Ultra-widefield fundus photograph: 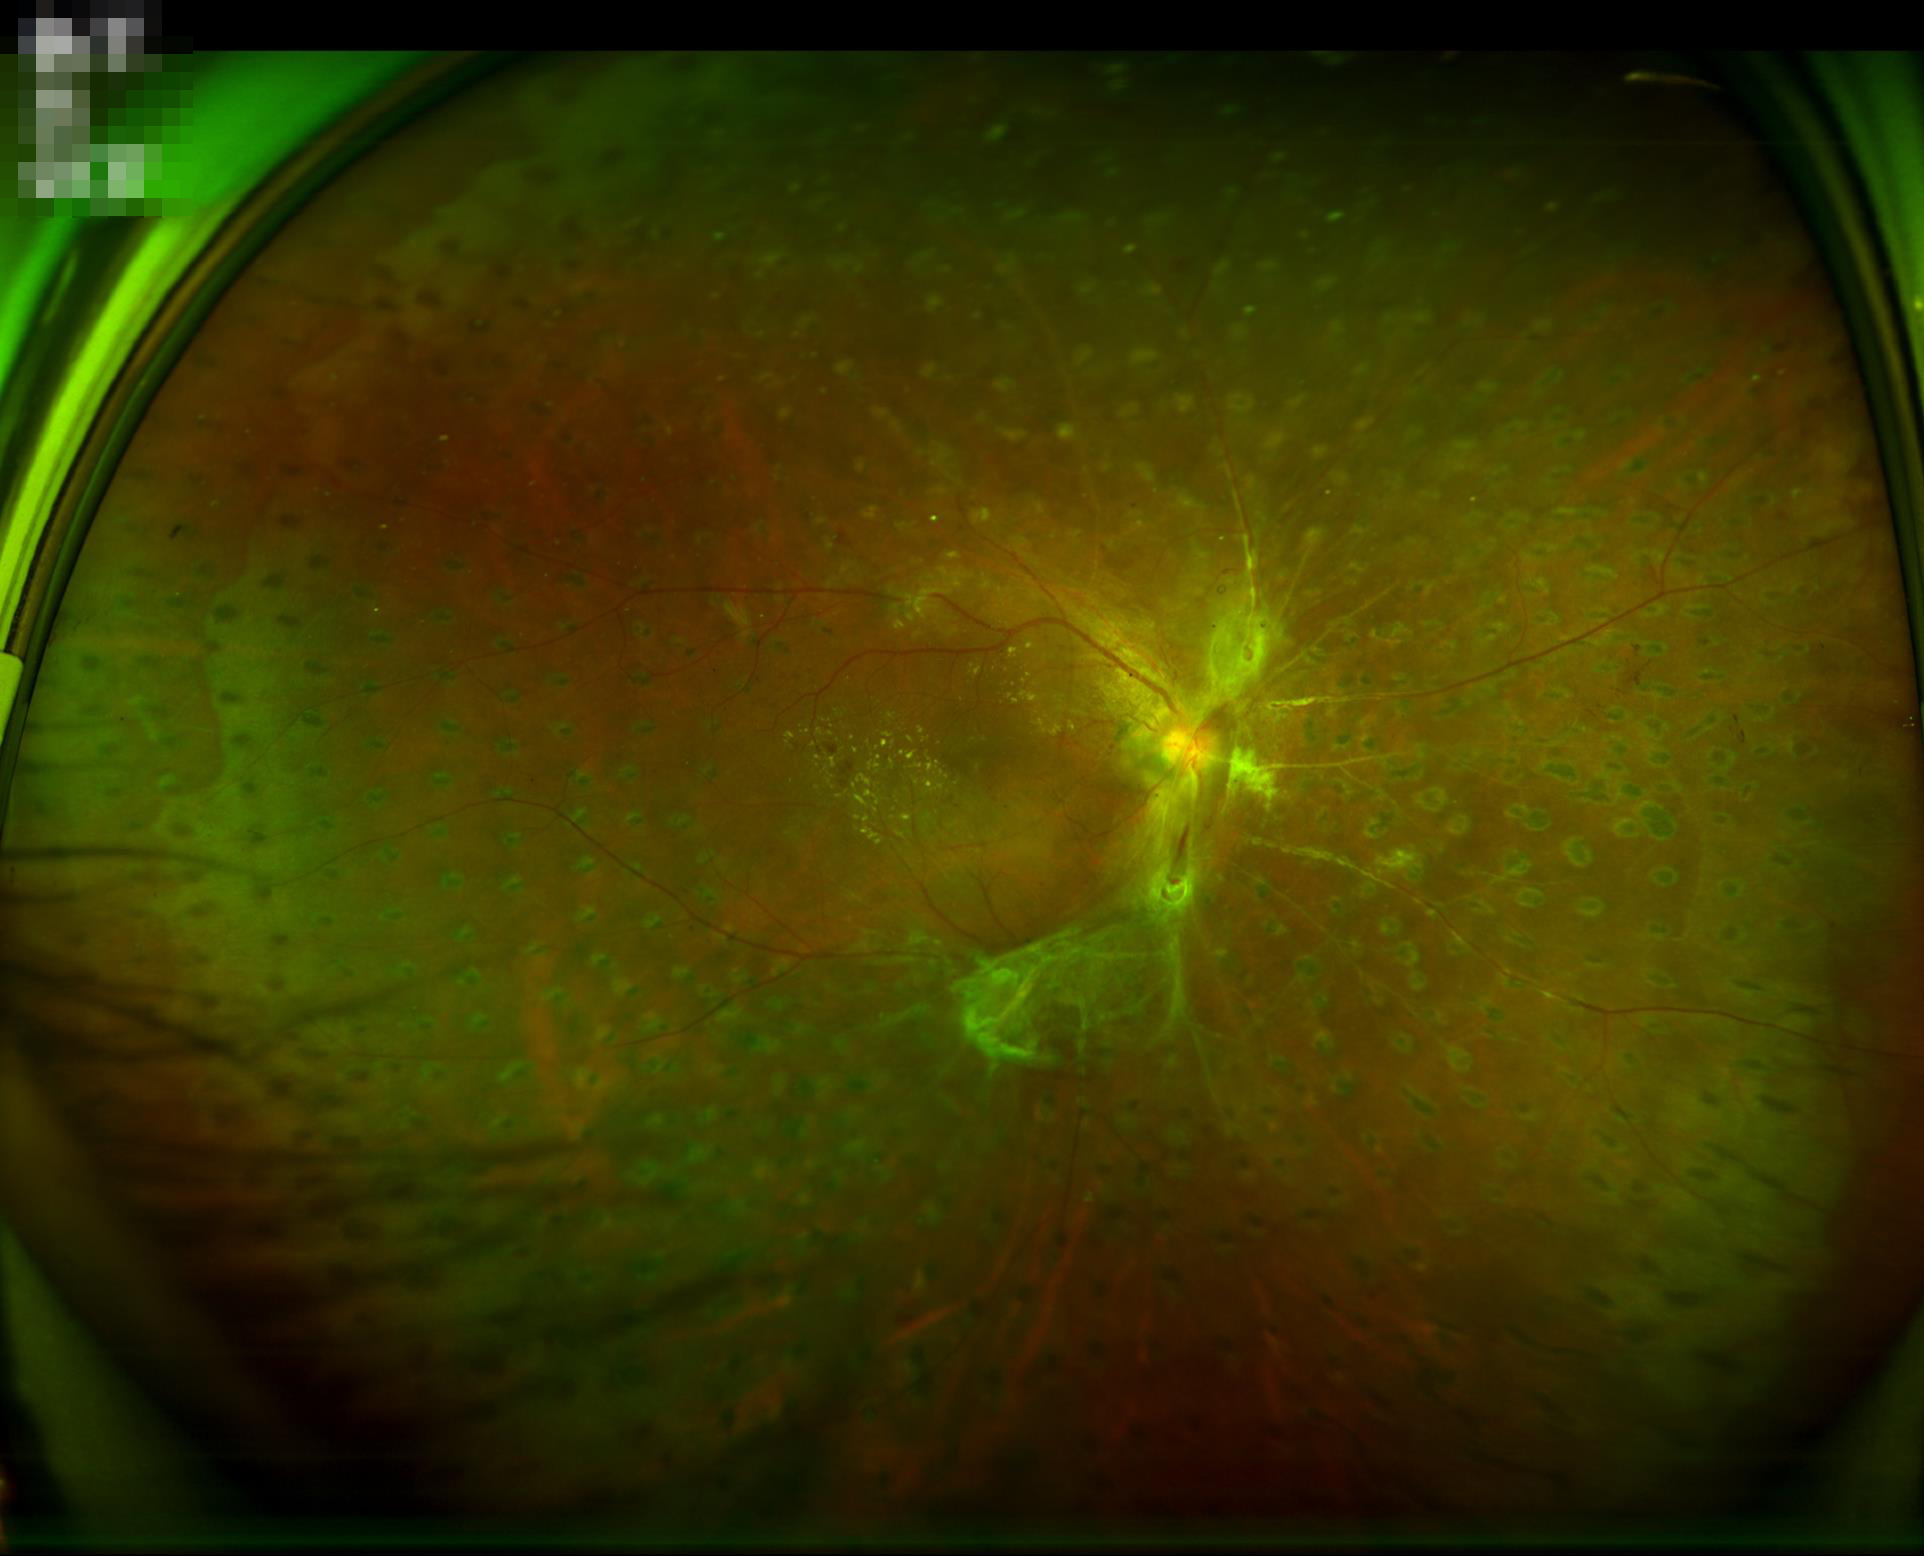

Illumination and color balance are good. No noticeable blur. Overall image quality is poor.